45° FOV.
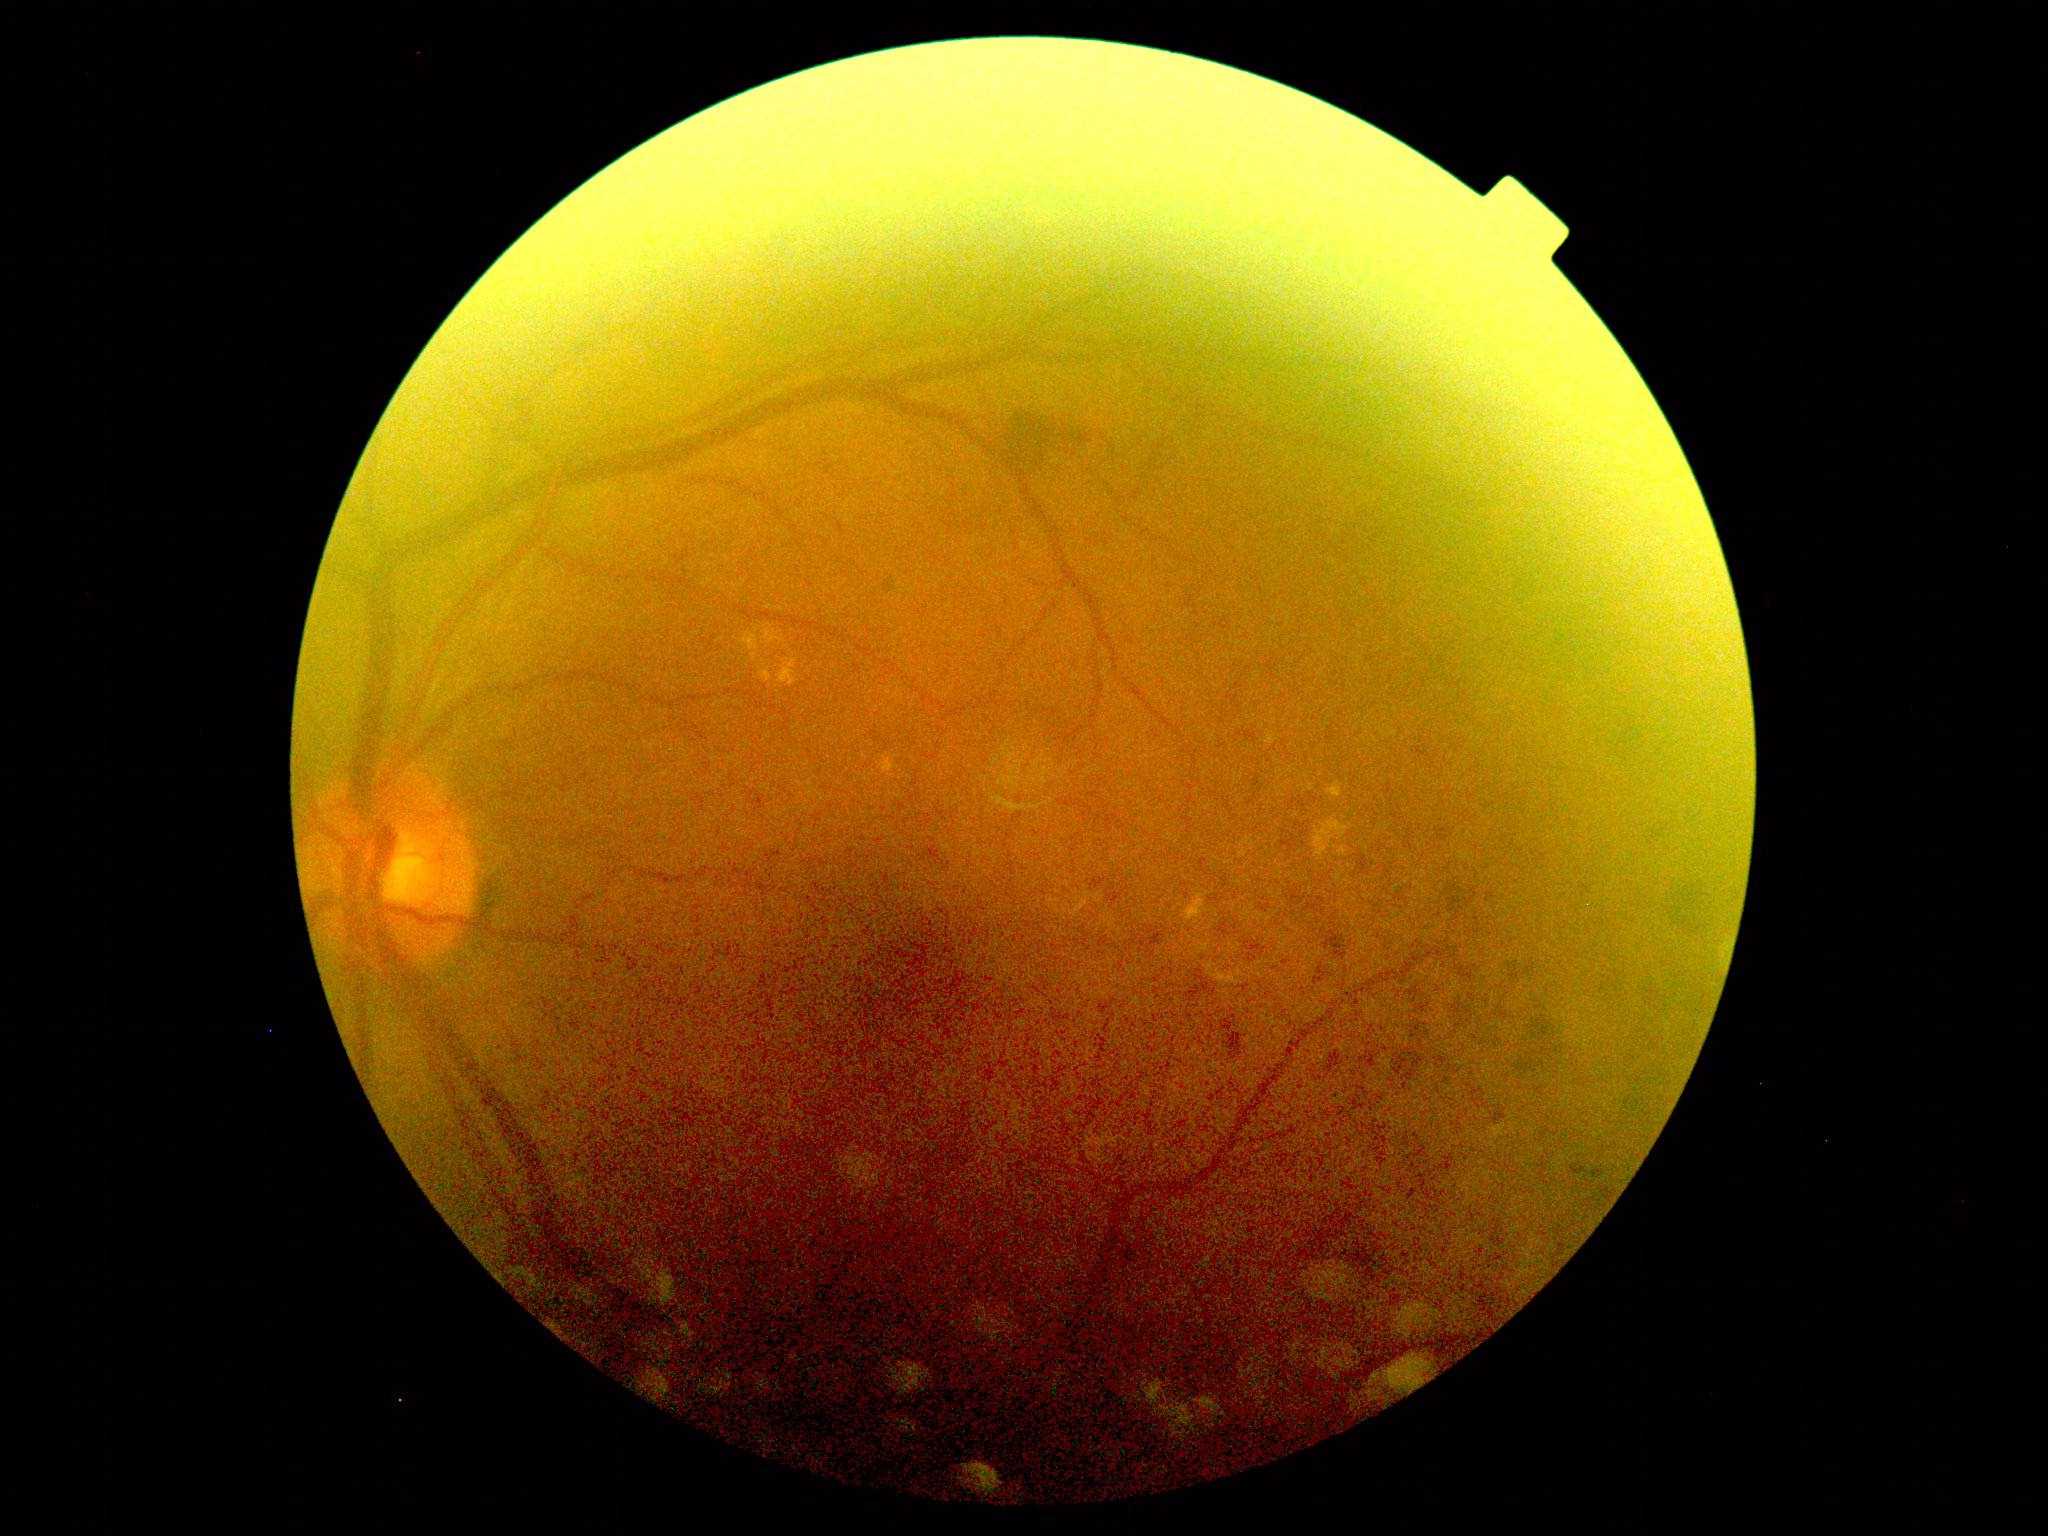 Diabetic retinopathy (DR): grade 2 (moderate NPDR).